CFP: 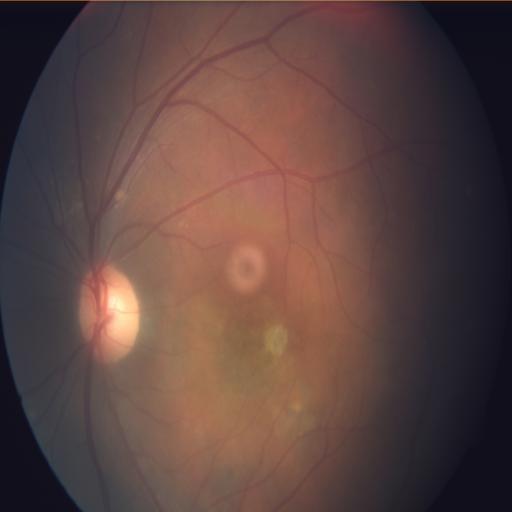

Showing tilted disc.